Image size 848x848
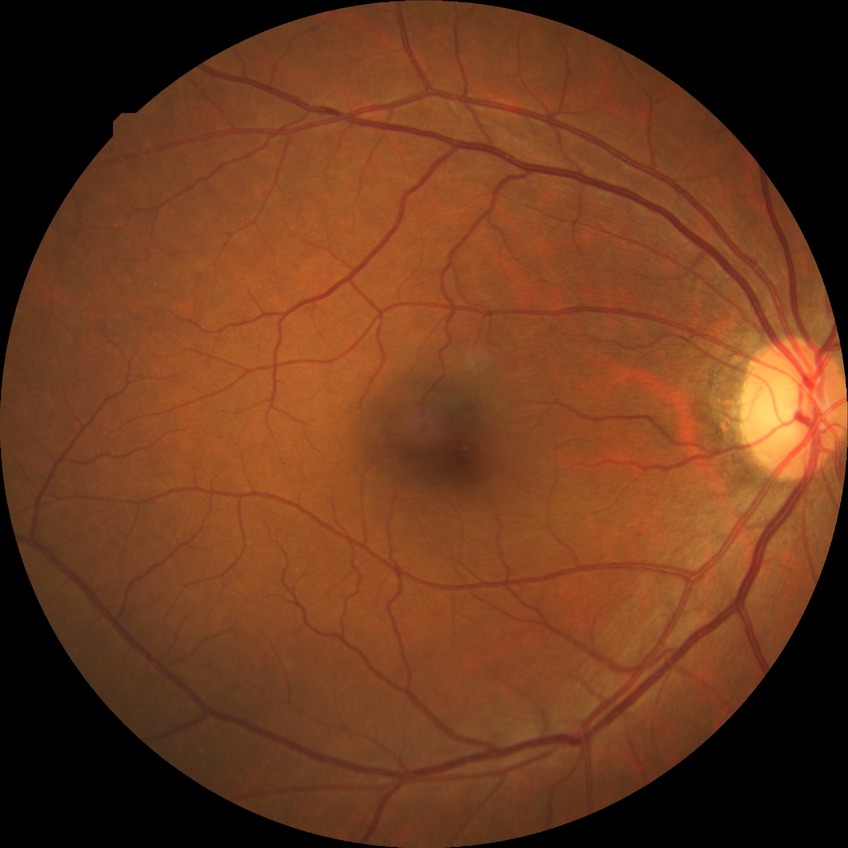
{
  "davis_grade": "no diabetic retinopathy (NDR)"
}